Retinal fundus photograph, acquired with a NIDEK AFC-230, nonmydriatic fundus photograph
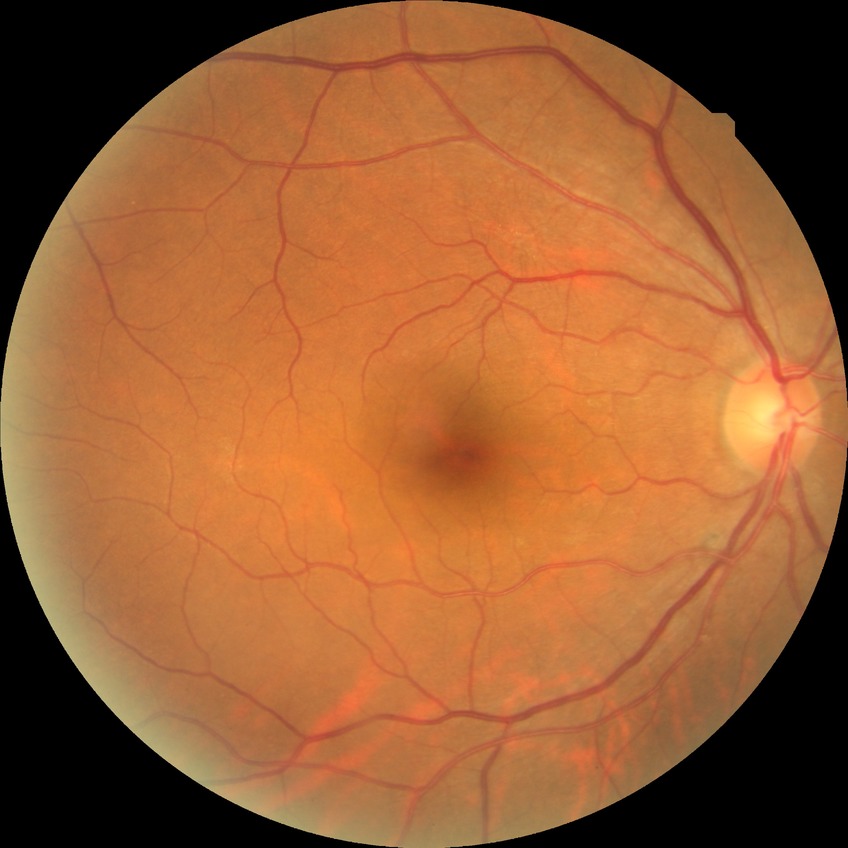

Modified Davis grading: no diabetic retinopathy.